848x848, diabetic retinopathy graded by the modified Davis classification — 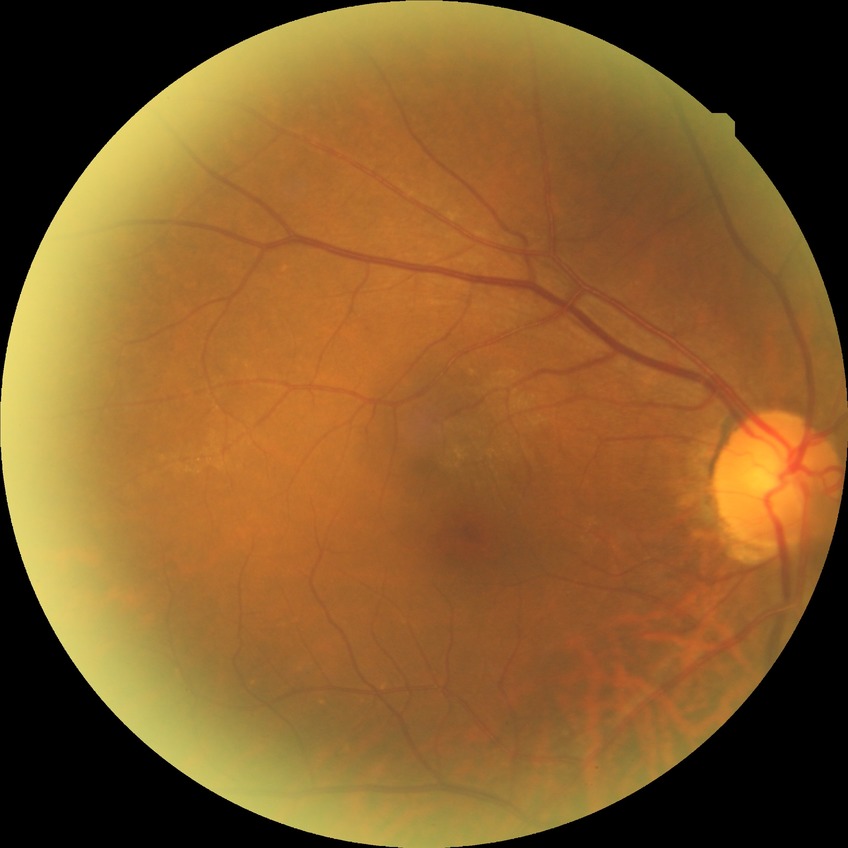

Modified Davis grading is no diabetic retinopathy.